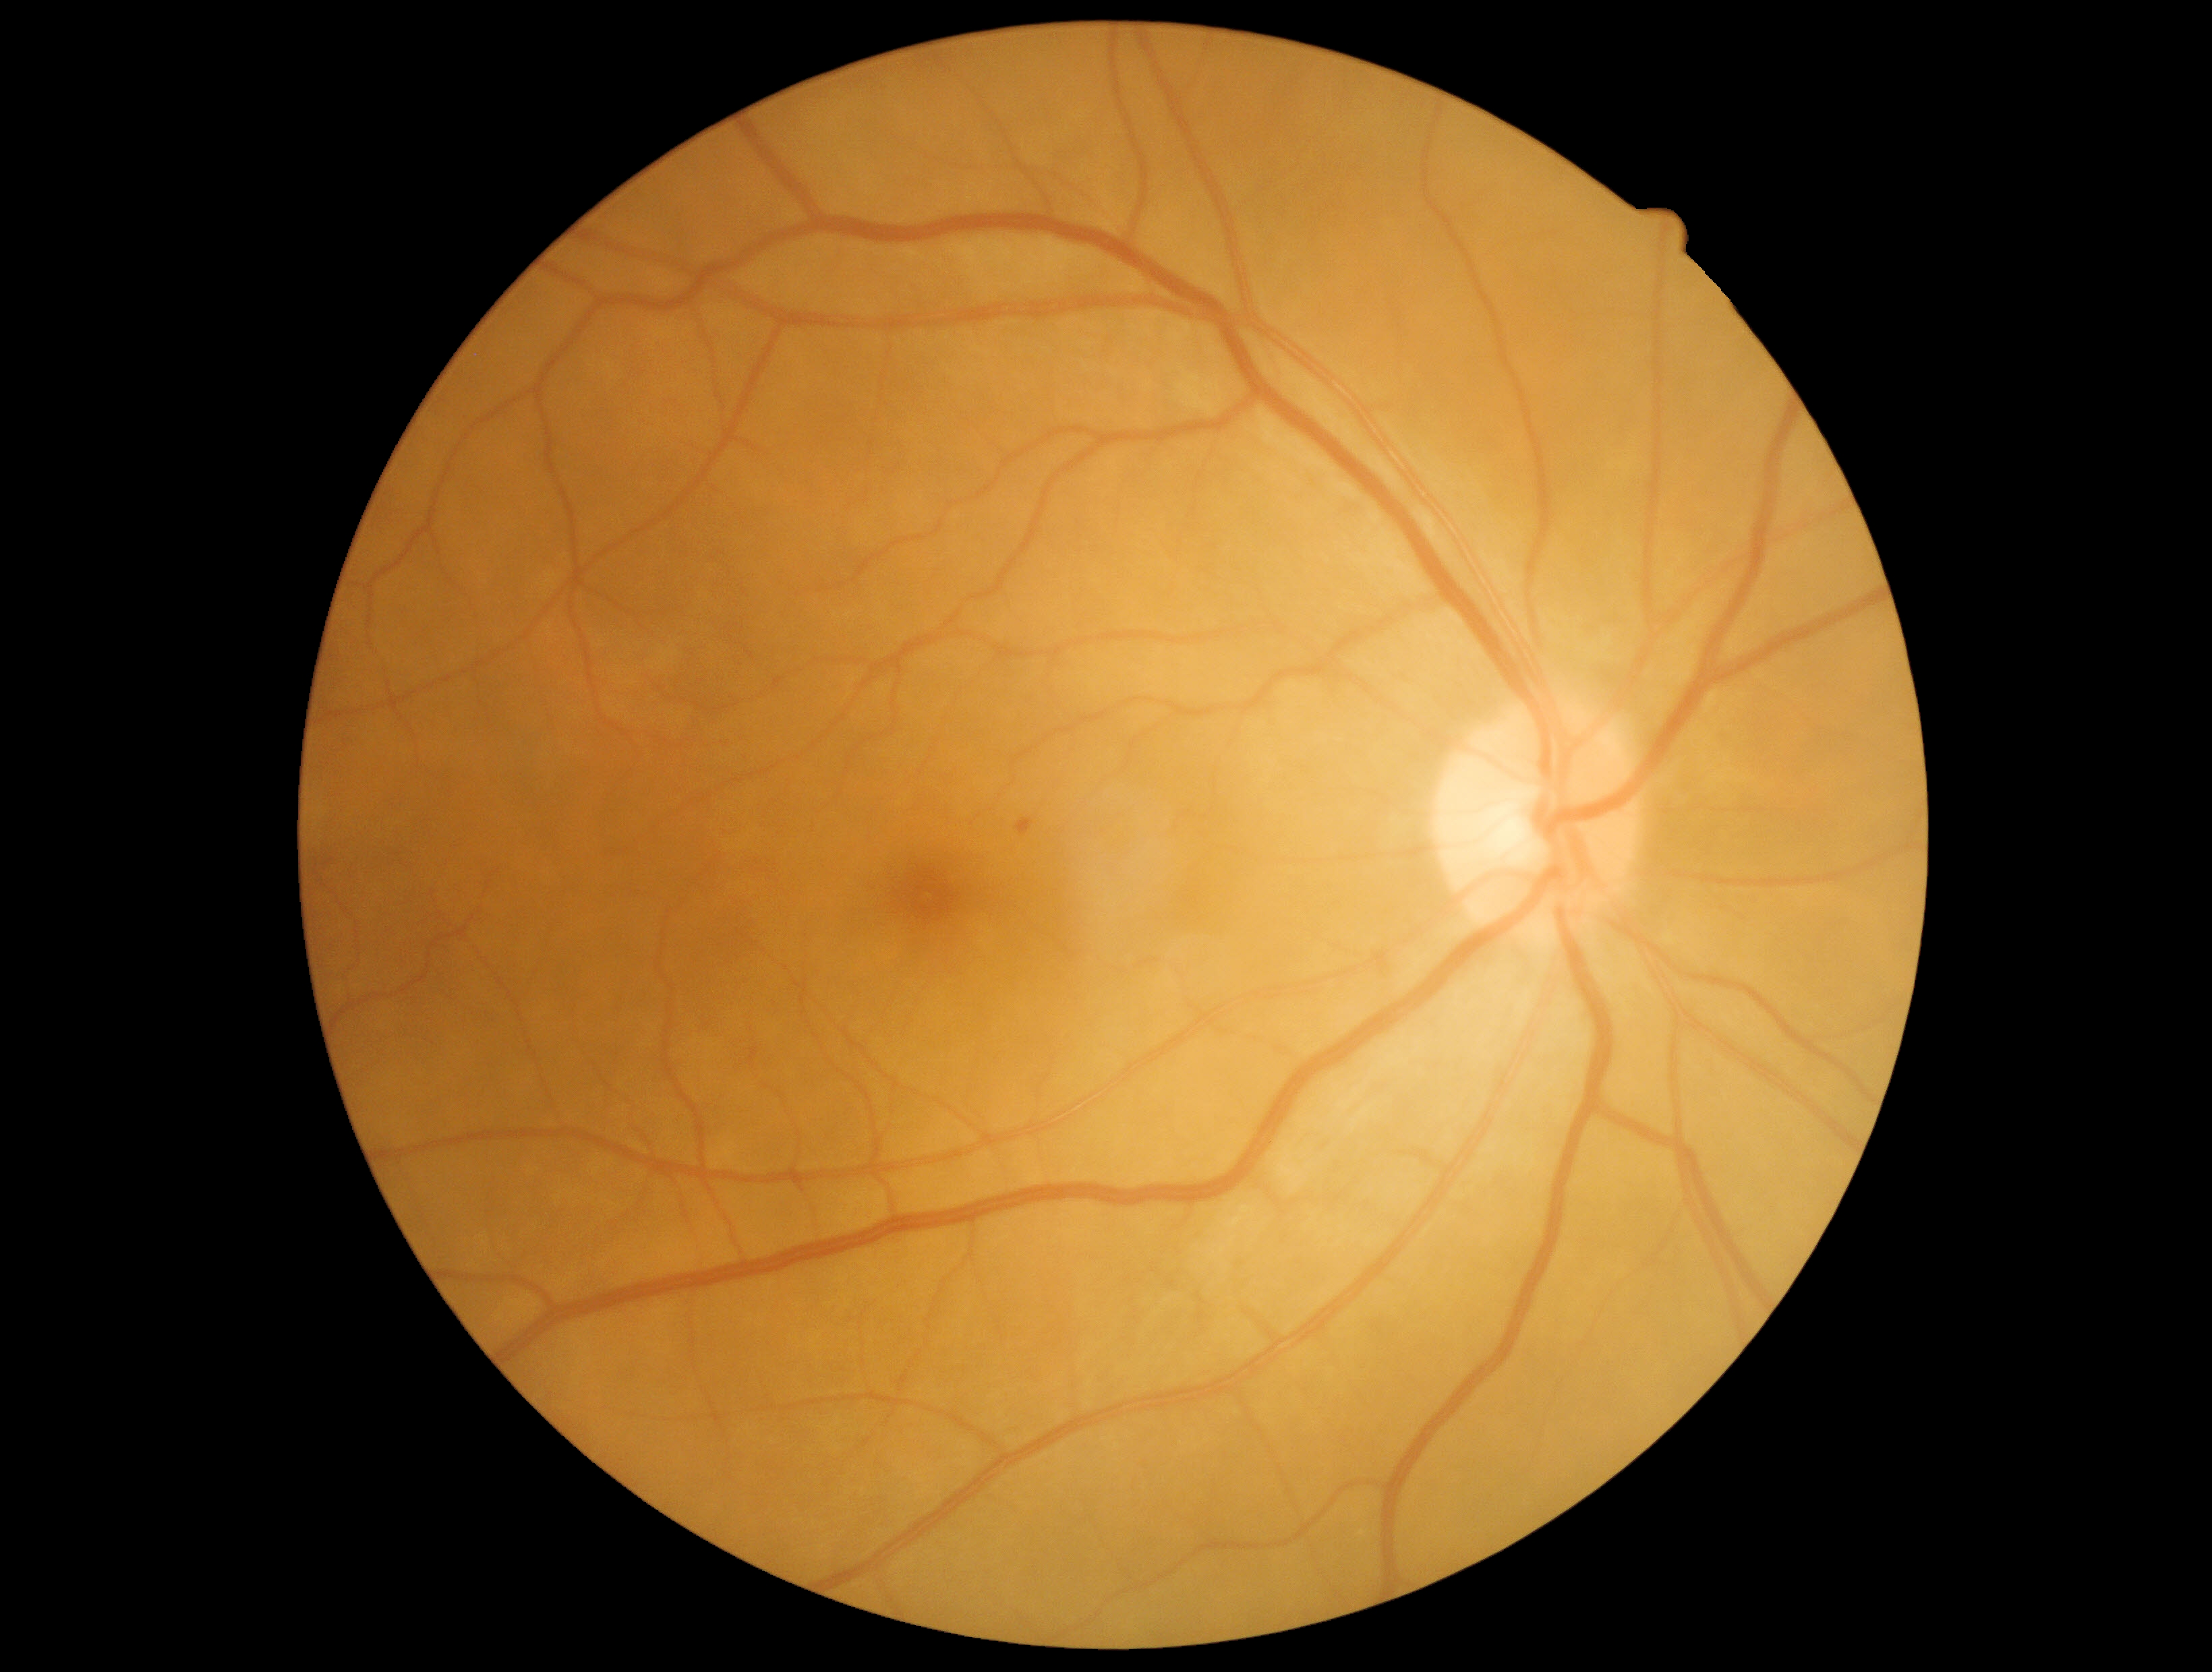 dr_grade: 1
lesions:
  se: []
  ex: []
  he: []
  ma:
    - {"x1": 1015, "y1": 818, "x2": 1034, "y2": 837}